ONH-centered crop from a color fundus image. 35° FOV before cropping:
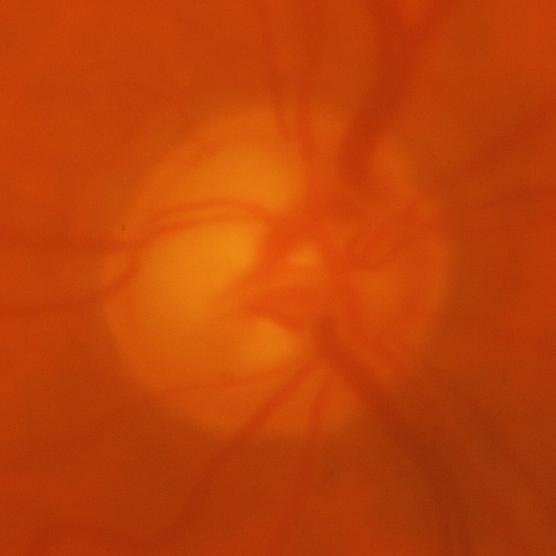
Showing glaucomatous optic neuropathy.